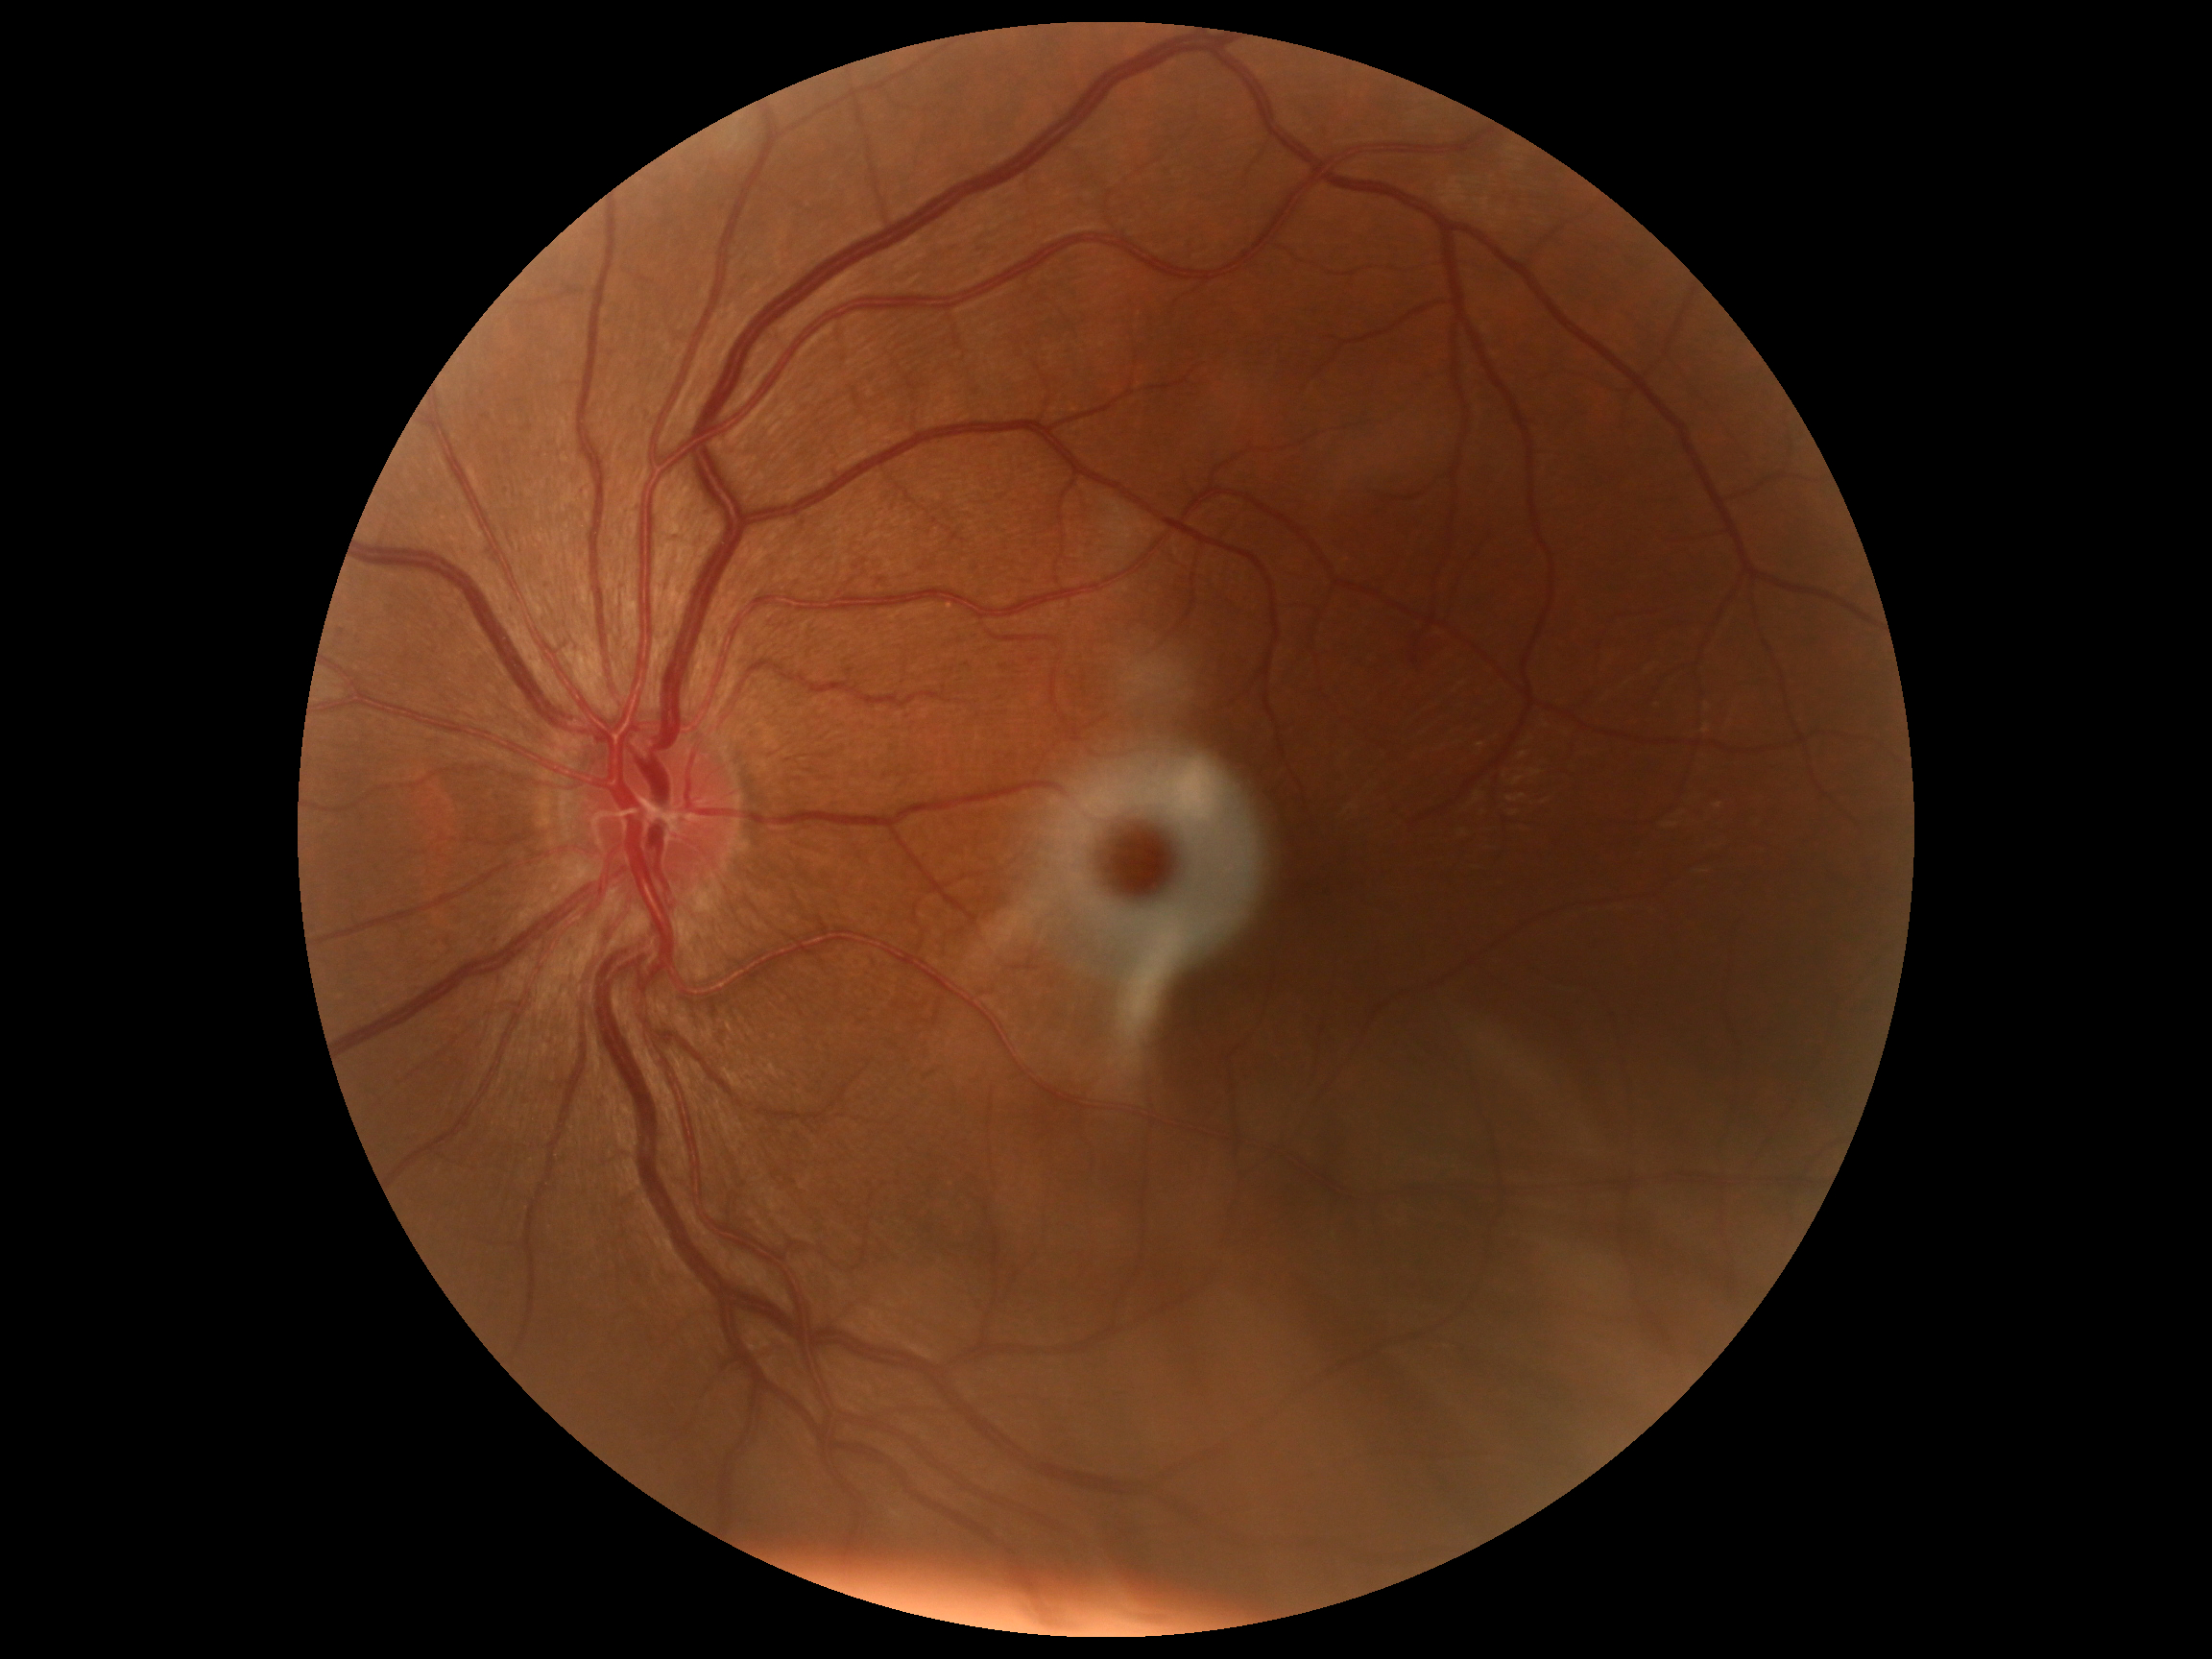

DR grade: no apparent diabetic retinopathy (0).